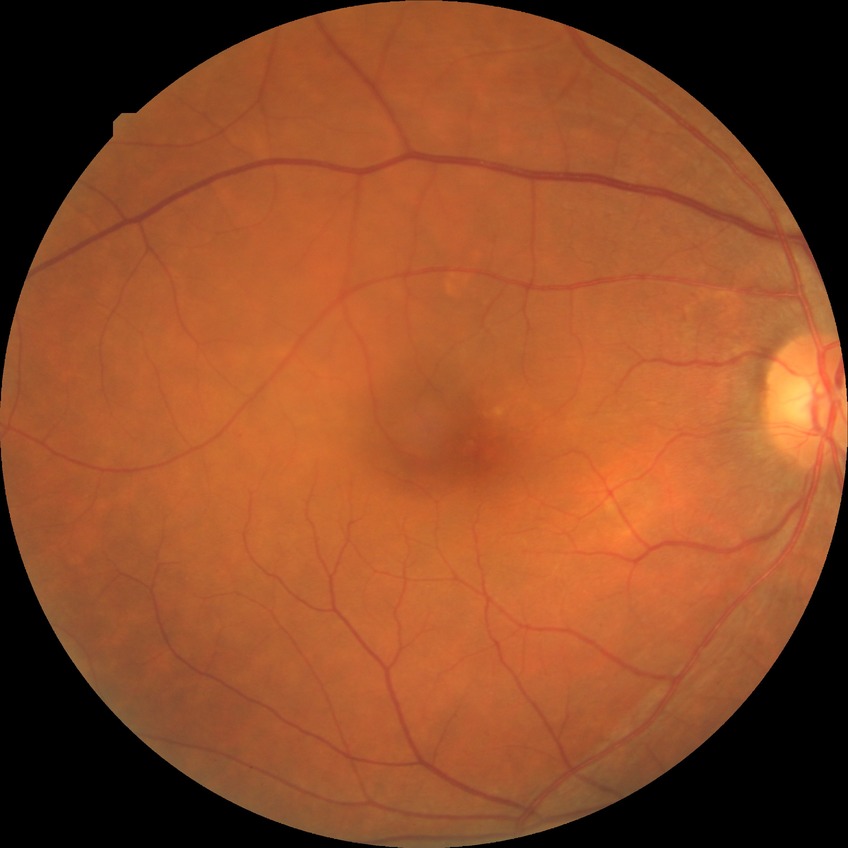

DR class: non-proliferative diabetic retinopathy. Modified Davis grading: simple diabetic retinopathy.